Diabetic retinopathy graded by the modified Davis classification; nonmydriatic fundus photograph
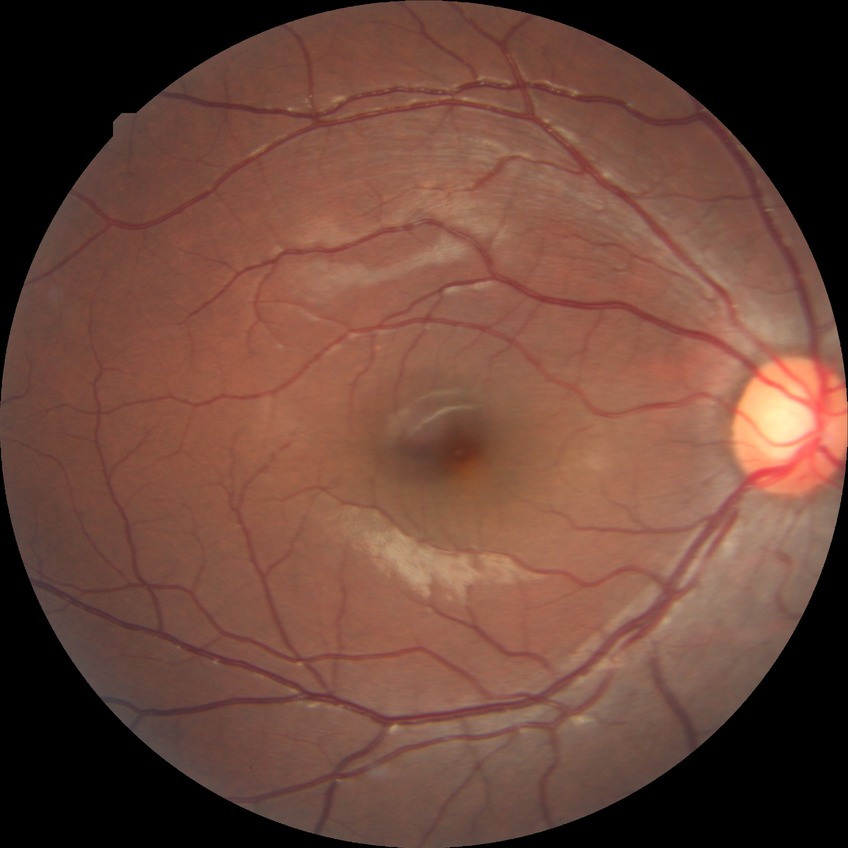   davis_grade: NDR (no diabetic retinopathy)